Color fundus photograph; modified Davis classification; camera: NIDEK AFC-230; nonmydriatic
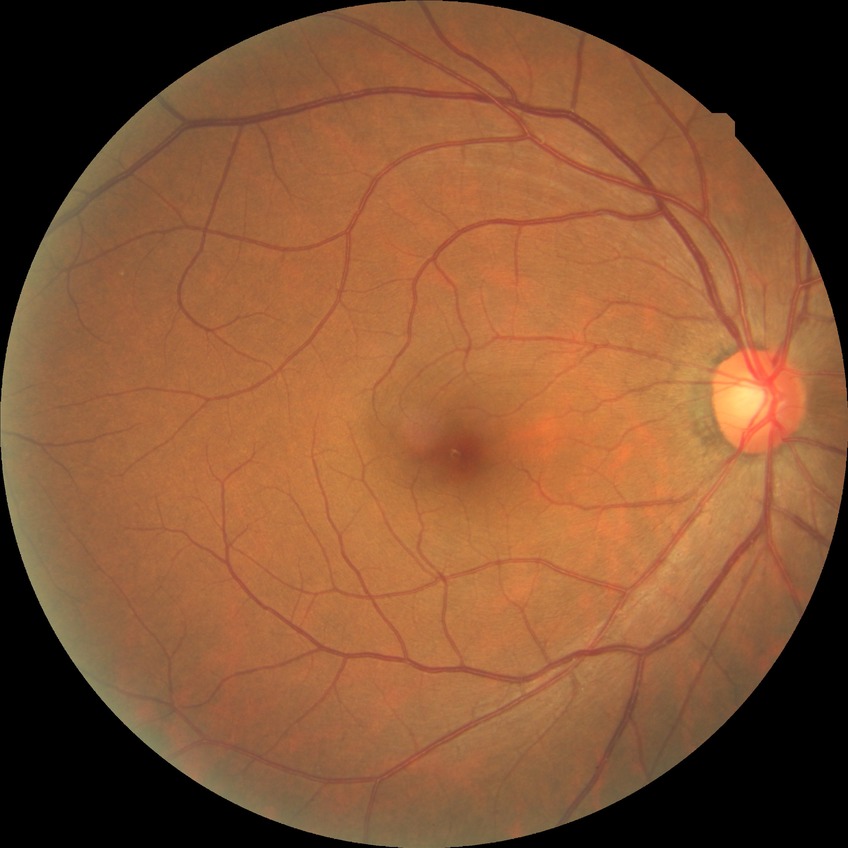
• retinopathy stage: no diabetic retinopathy